Modified Davis grading · 848 by 848 pixels:
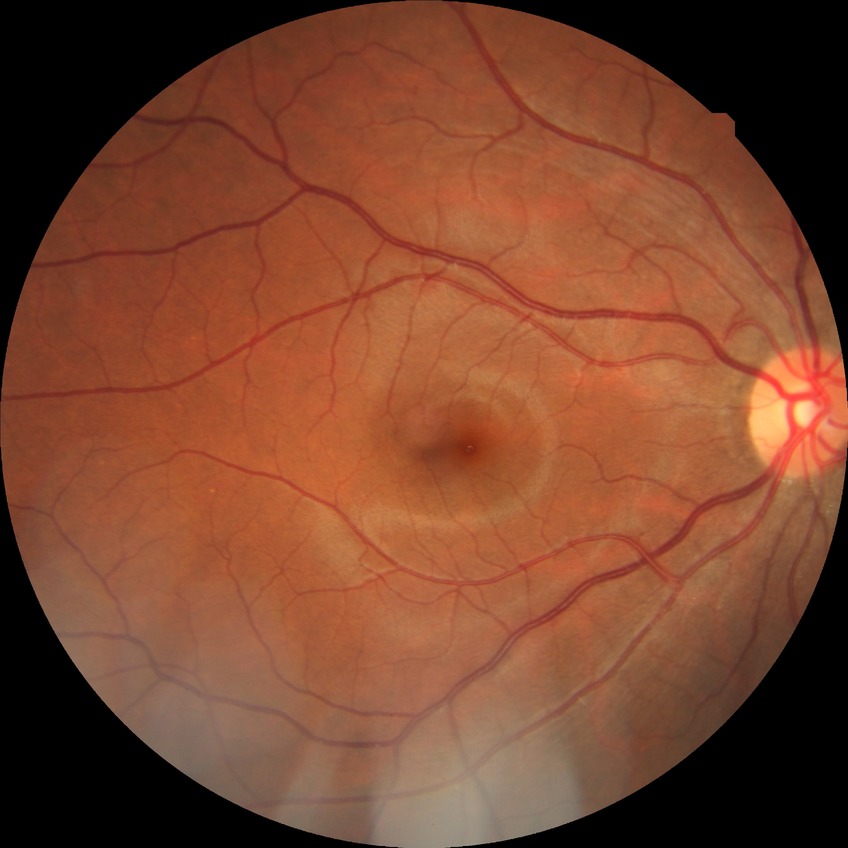 Diabetic retinopathy (DR) is no diabetic retinopathy (NDR).